Phoenix ICON, 100° FOV; image size 1240x1240; infant wide-field retinal image
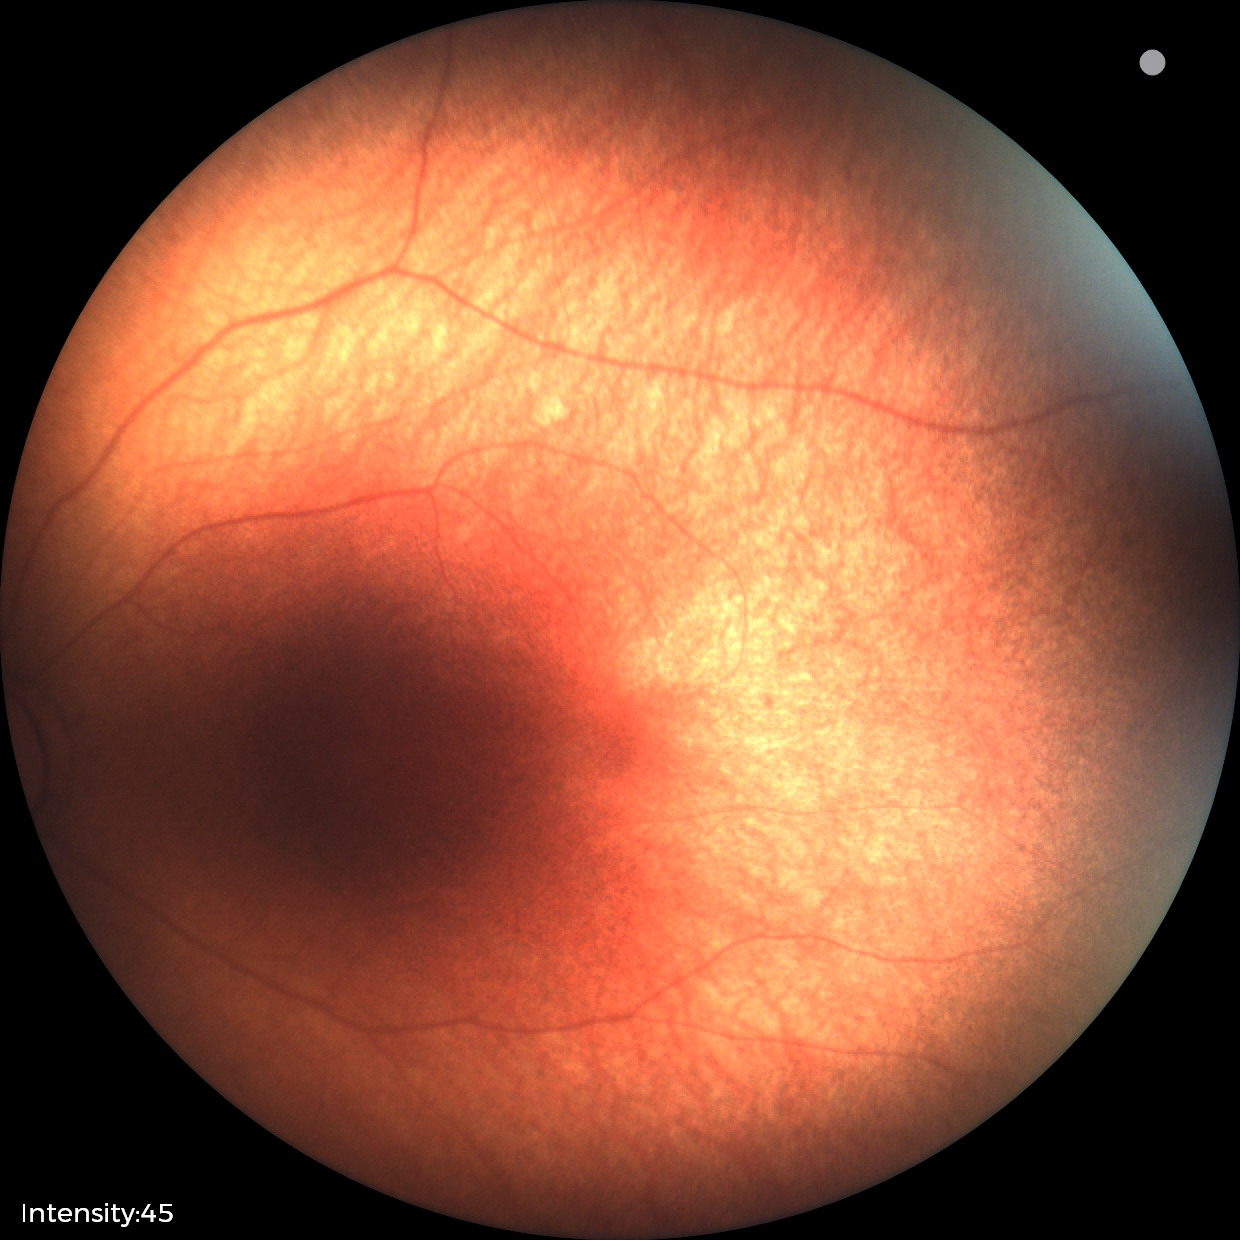

Screening: physiological retinal finding.